FOV: 45 degrees: 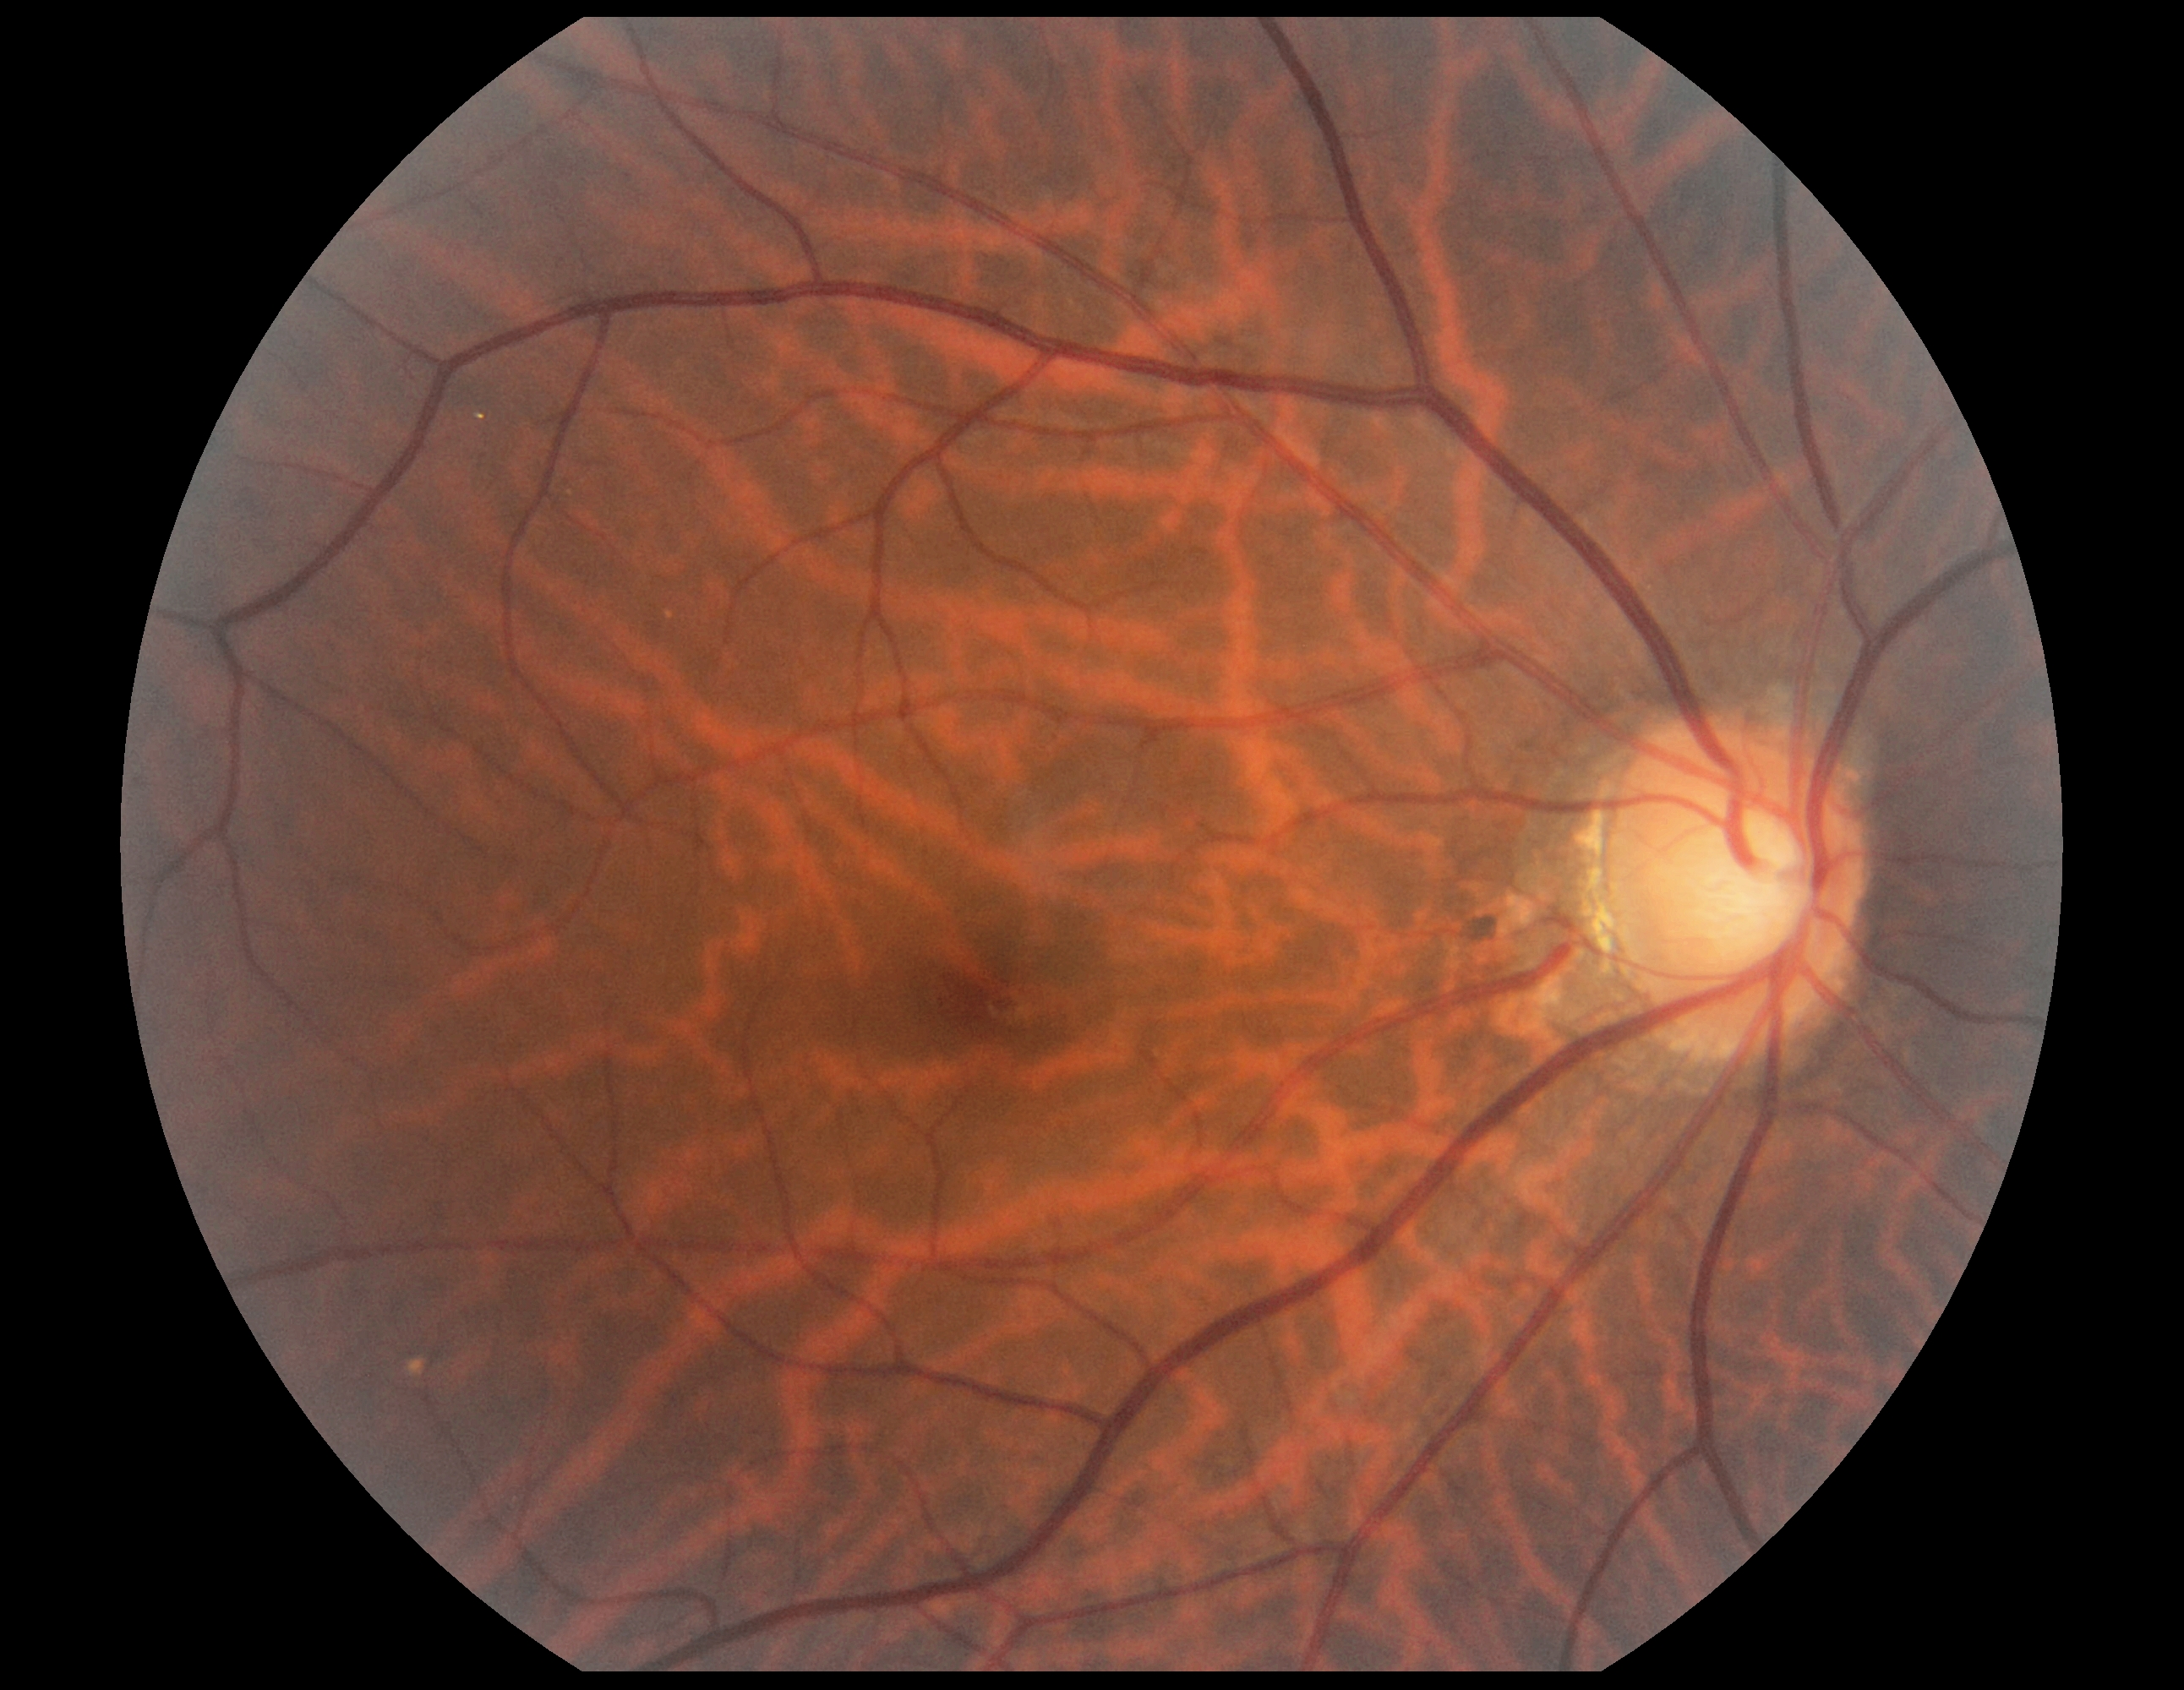 DR grade is 0 (no apparent retinopathy).